Centered on the optic disc:
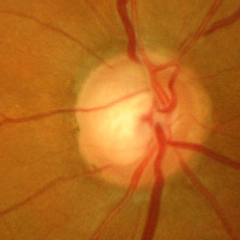
Advanced glaucoma.
Diagnostic criteria: near-total cupping of the optic nerve head, with or without severe visual field loss within the central 10 degrees of fixation.